Clarity RetCam 3, 130° FOV · wide-field fundus photograph from neonatal ROP screening:
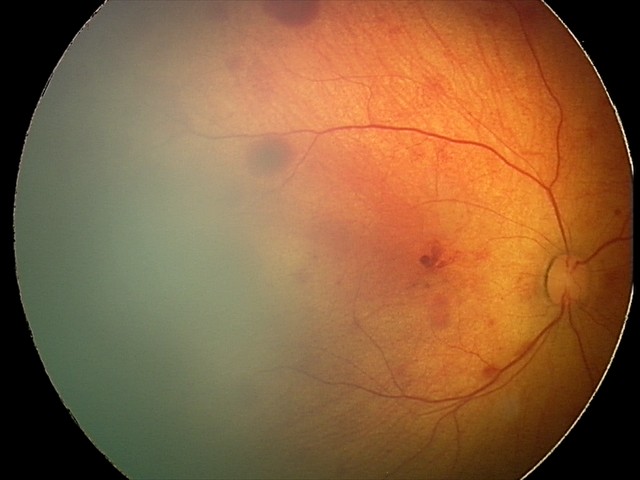

Screening diagnosis = retinal hemorrhages